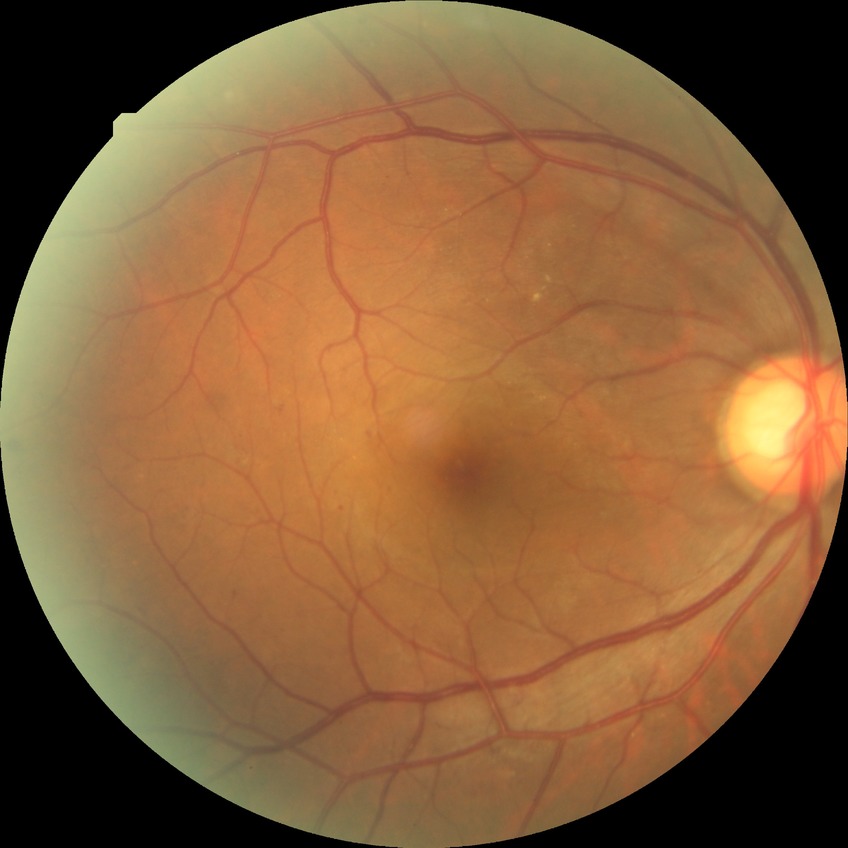
davis_grade: SDR (simple diabetic retinopathy)